FOV: 45 degrees; without pupil dilation:
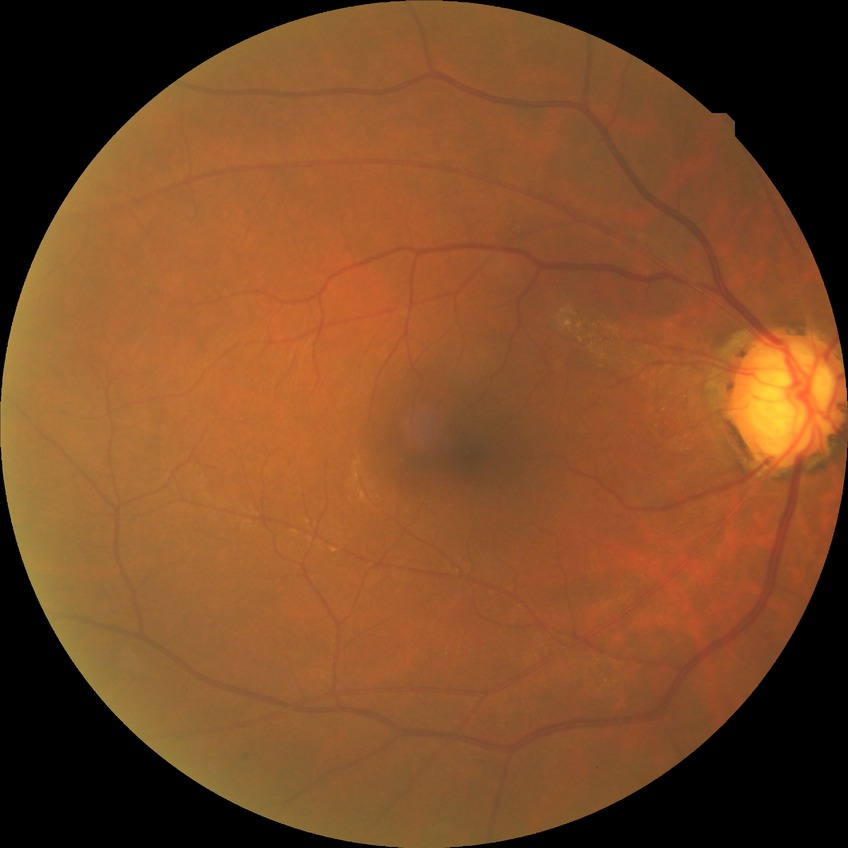

diabetic retinopathy (DR)=no diabetic retinopathy (NDR).